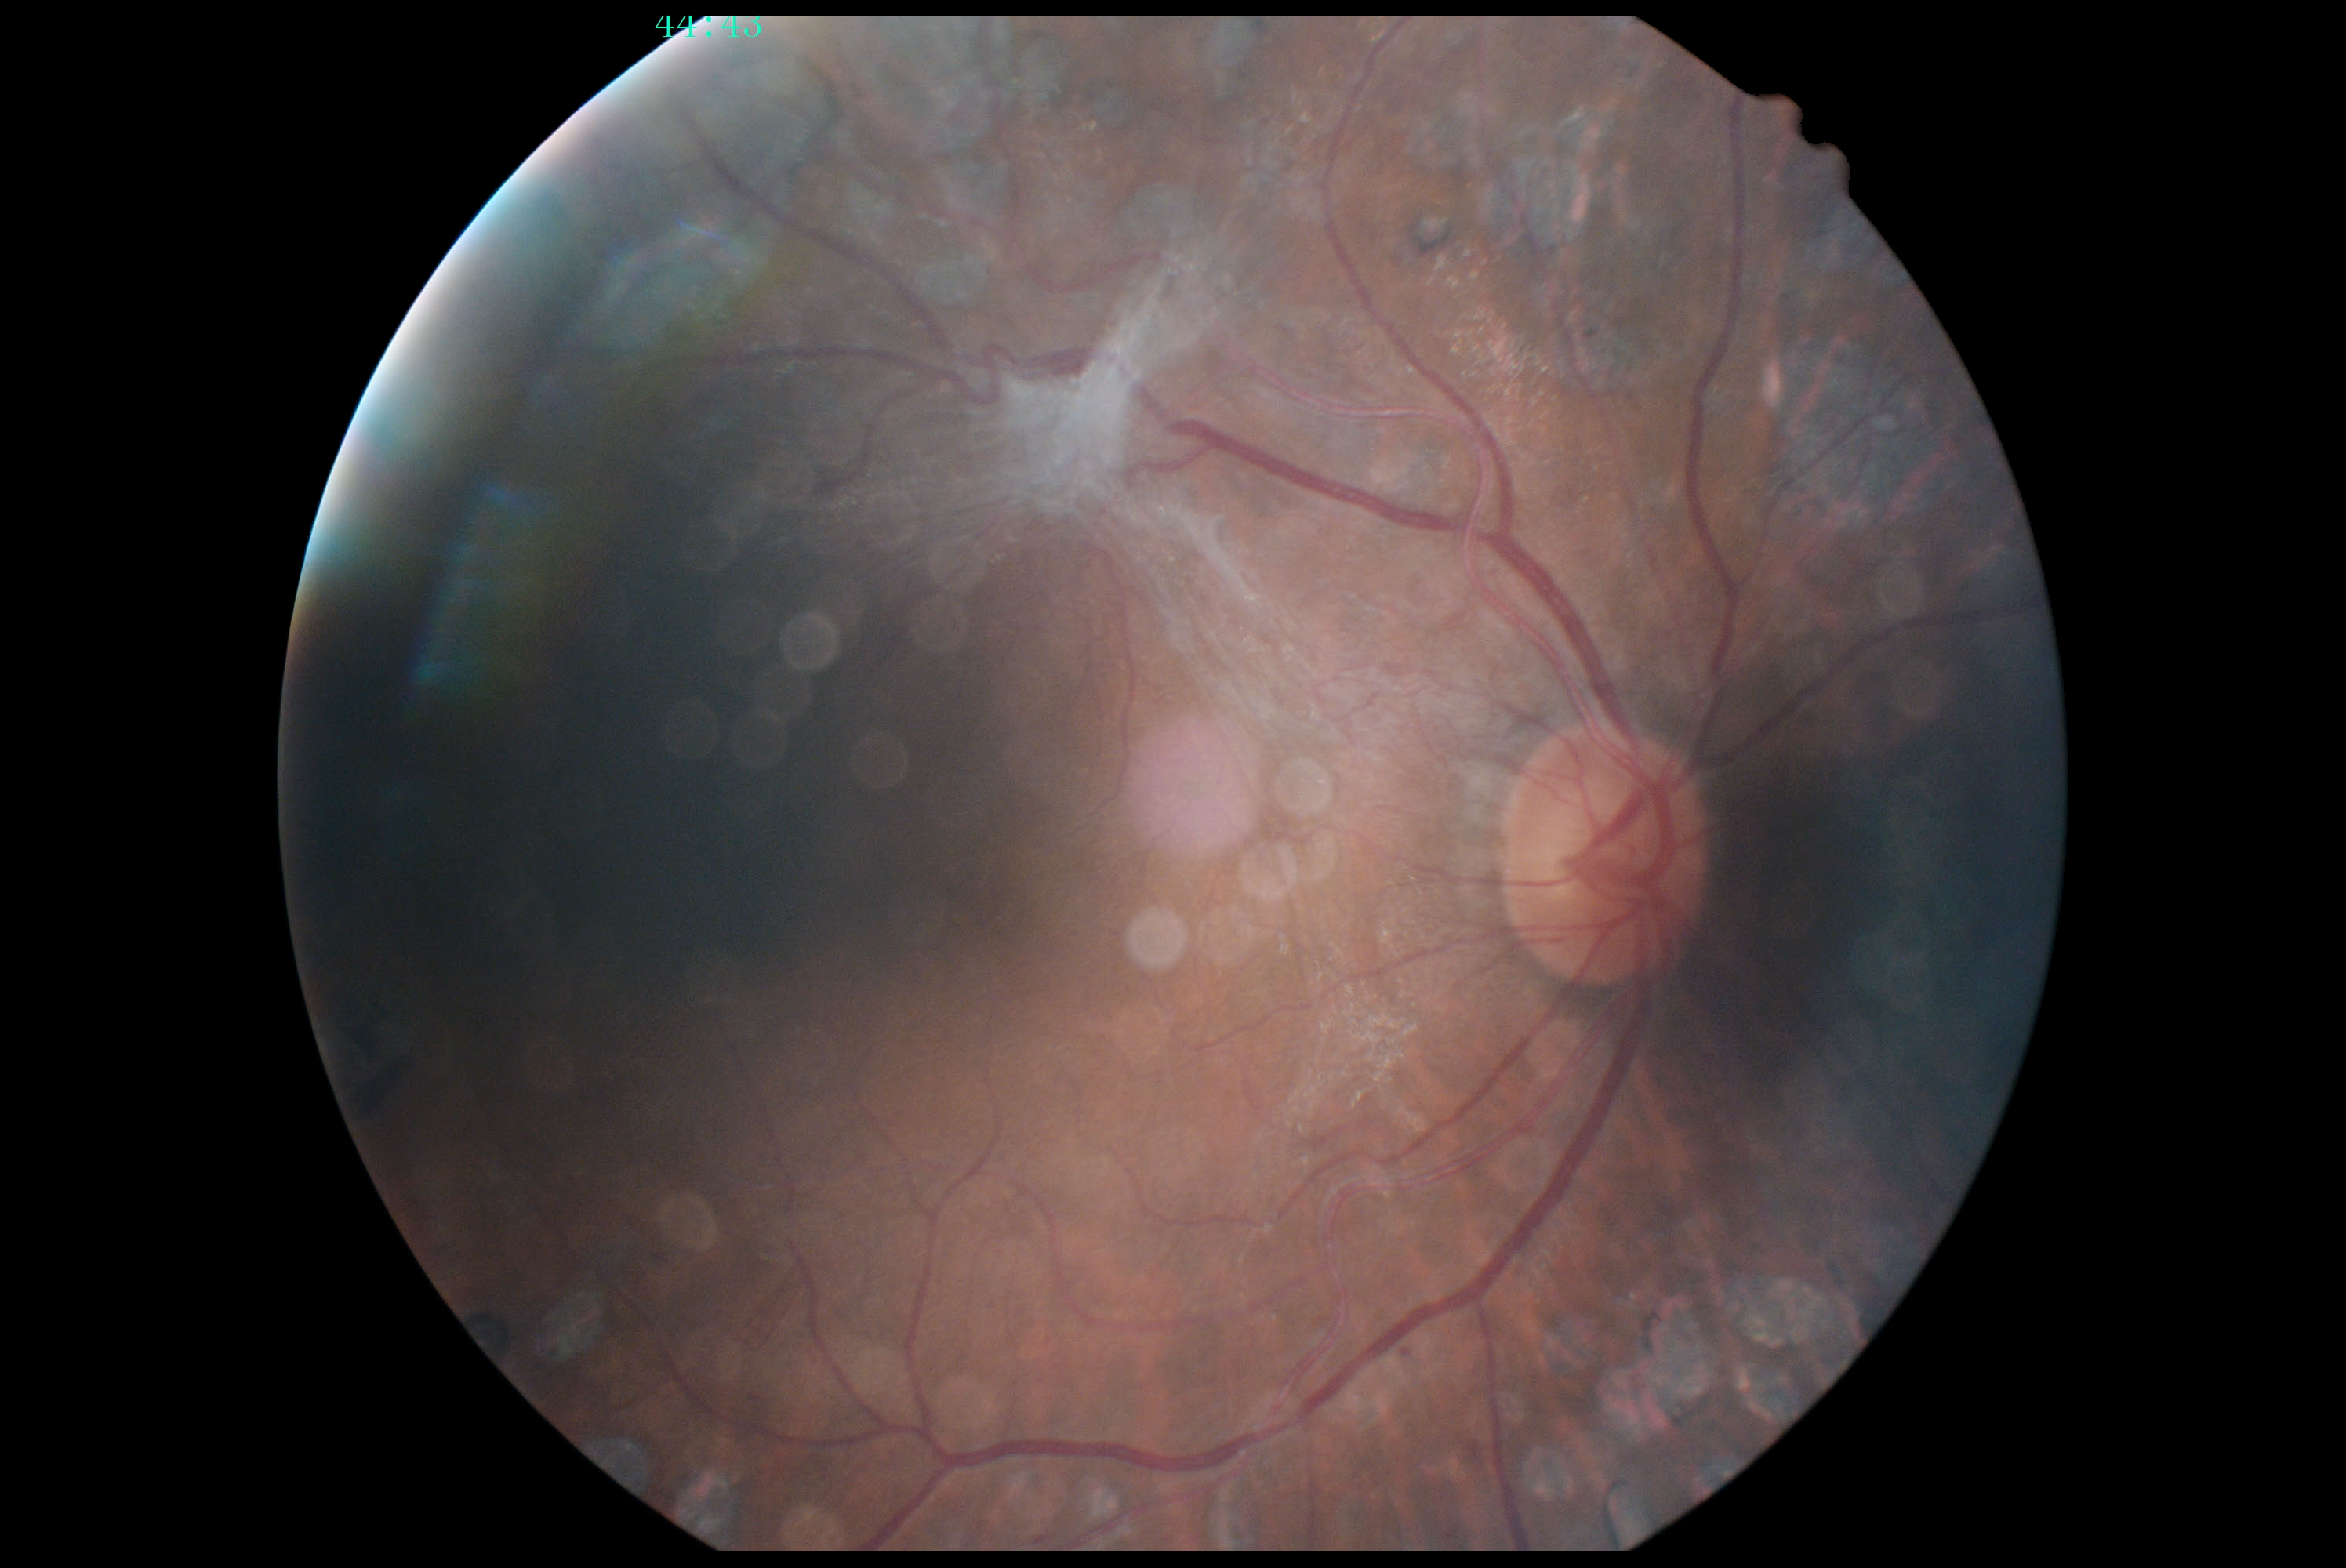
DR grade is PDR (4).